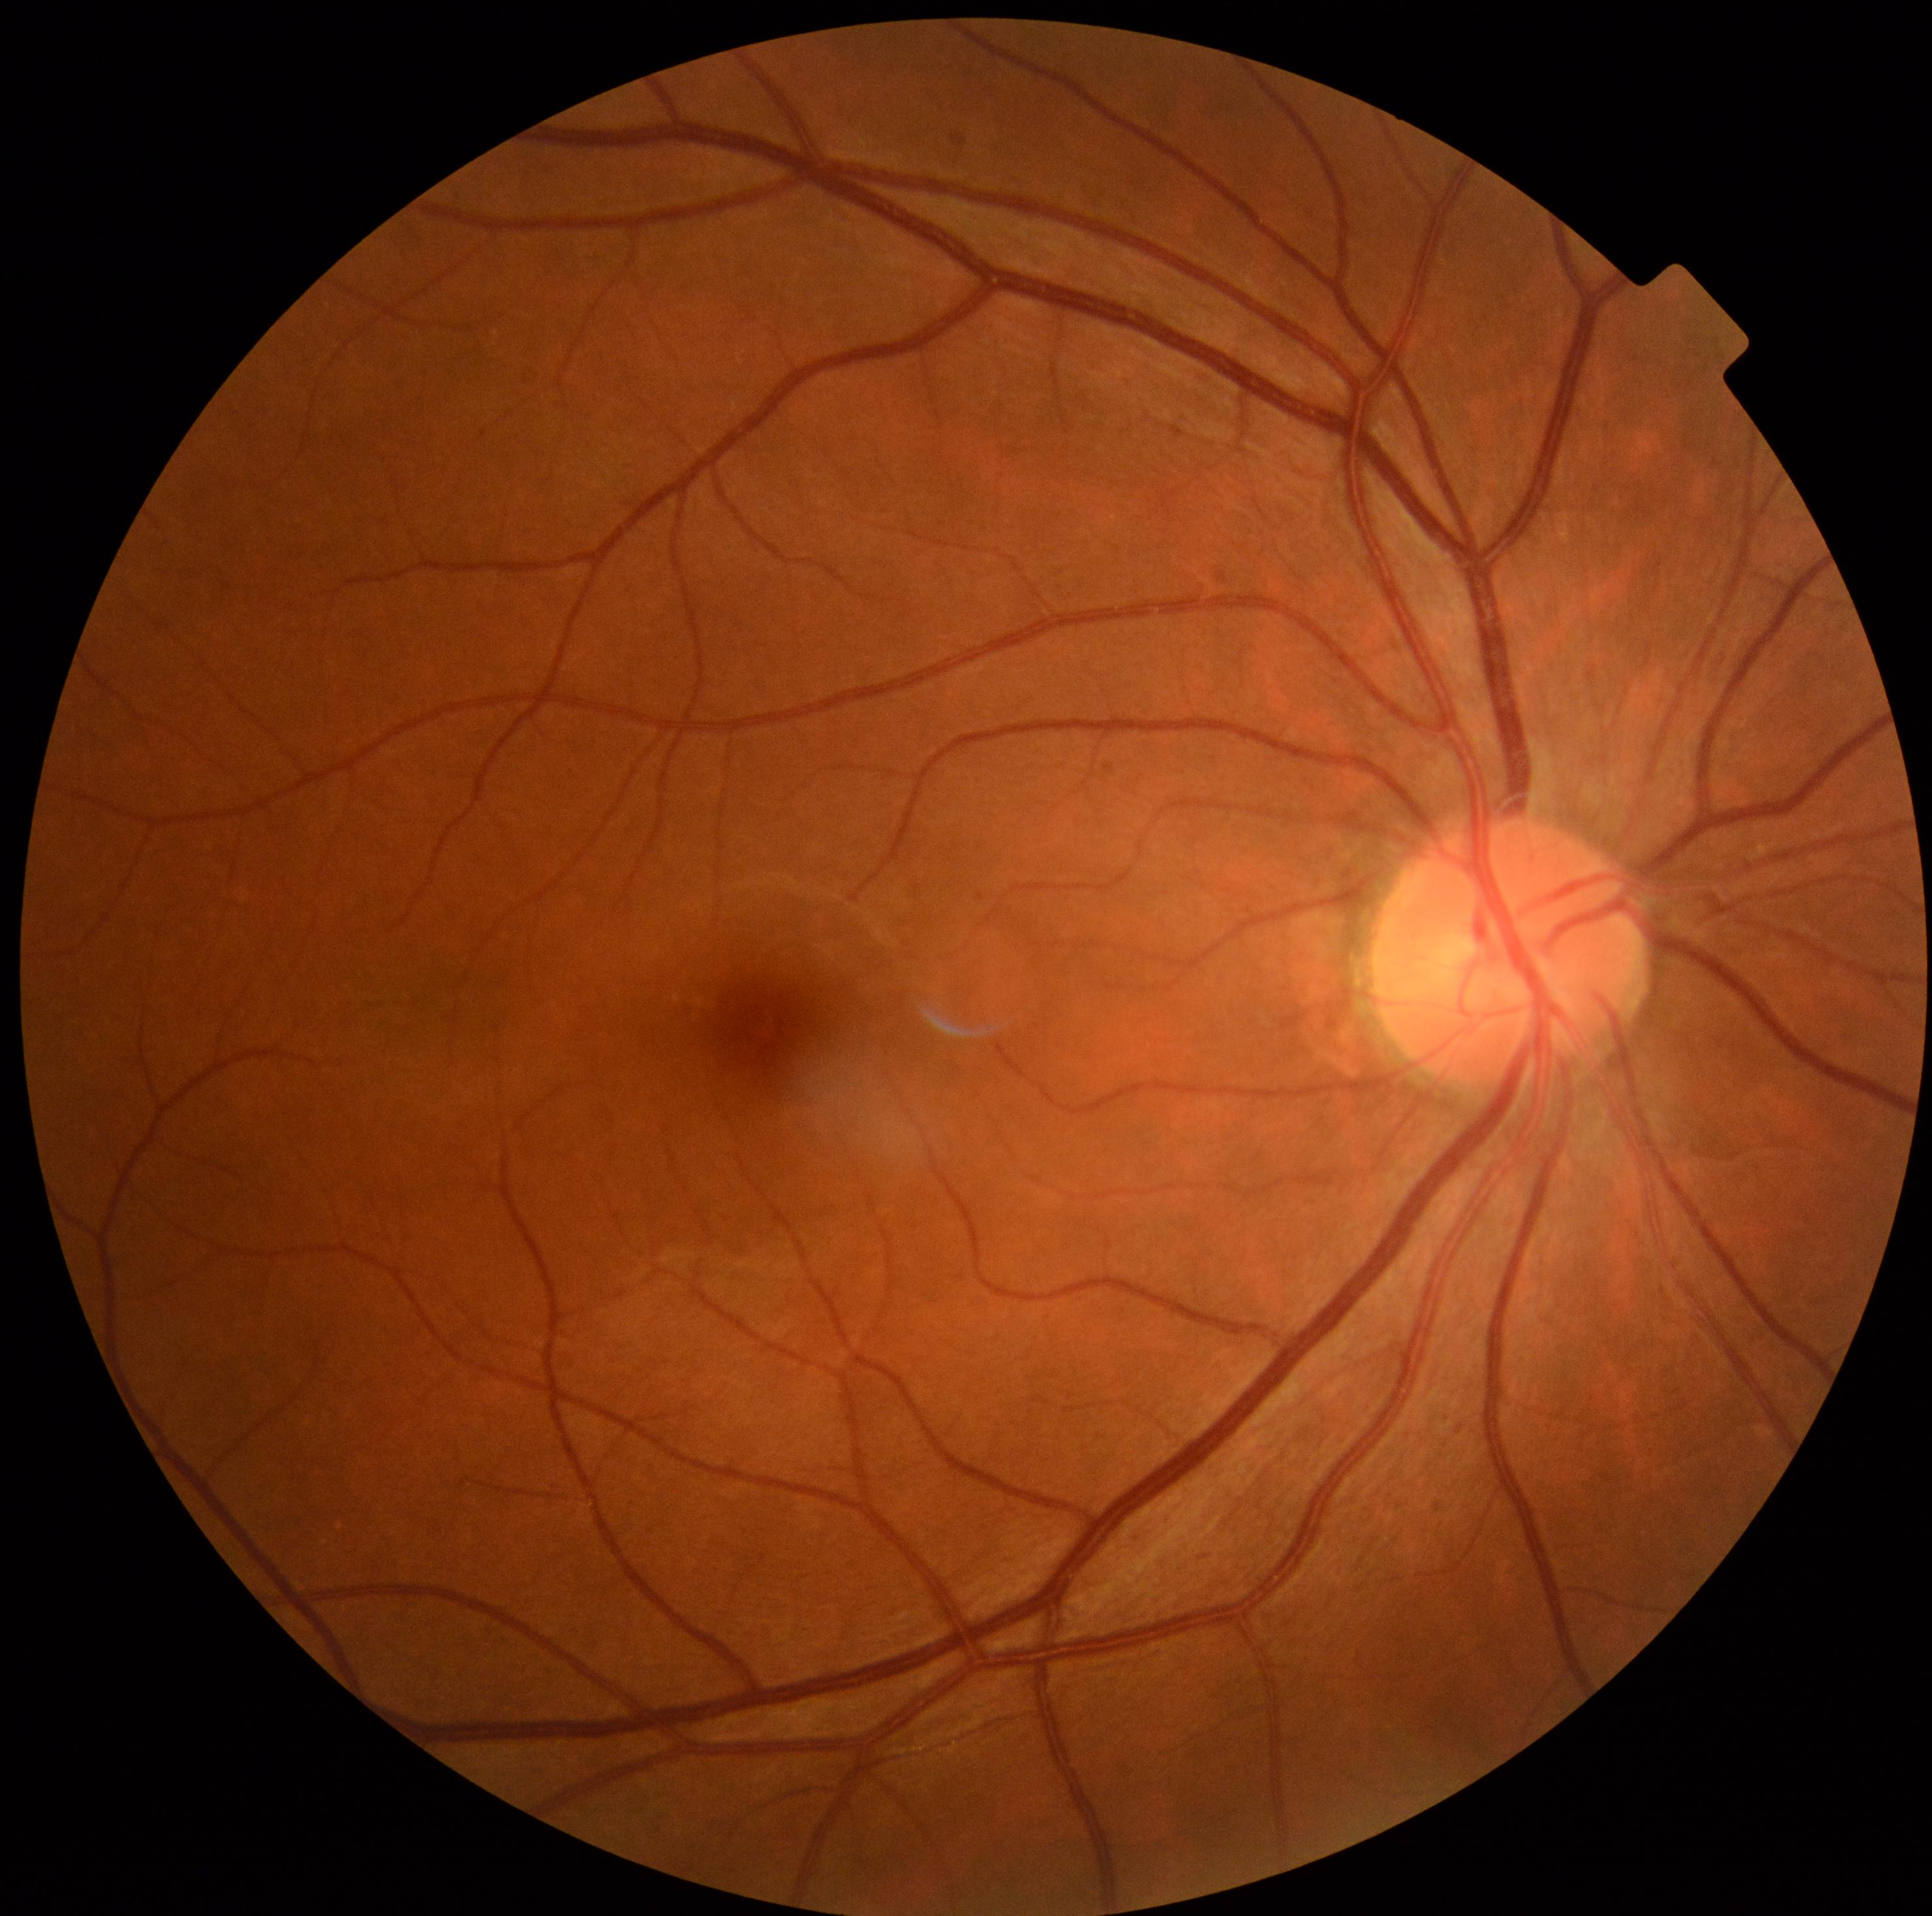

diabetic retinopathy (DR): grade 0 — no visible signs of diabetic retinopathy.